848 by 848 pixels. Color fundus photograph. DR severity per modified Davis staging:
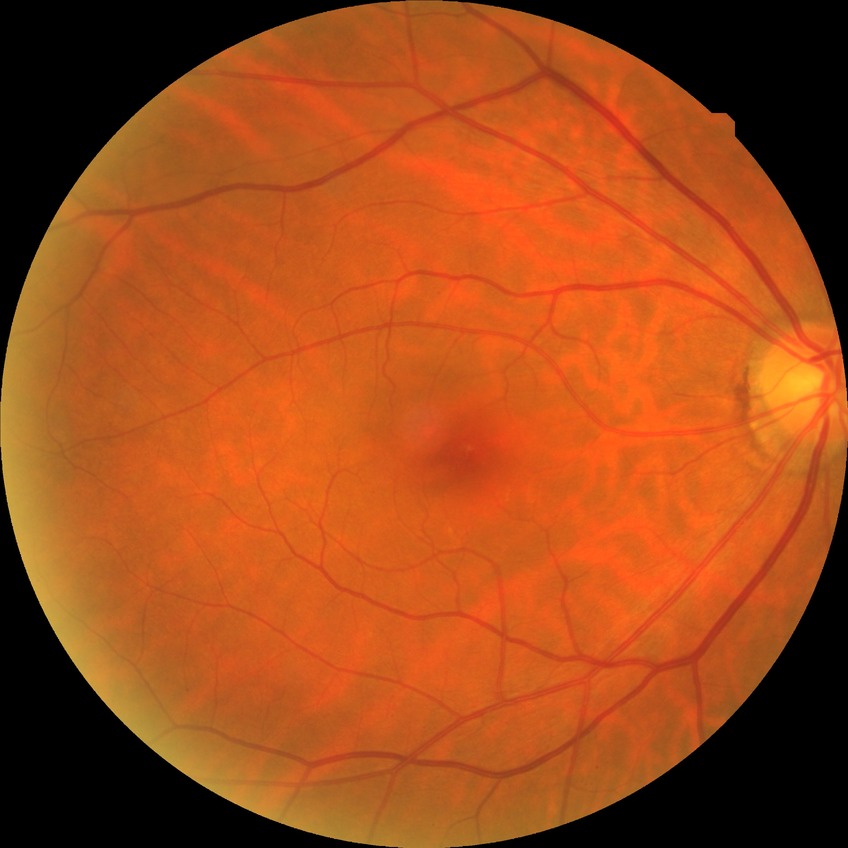

– retinopathy stage: no diabetic retinopathy